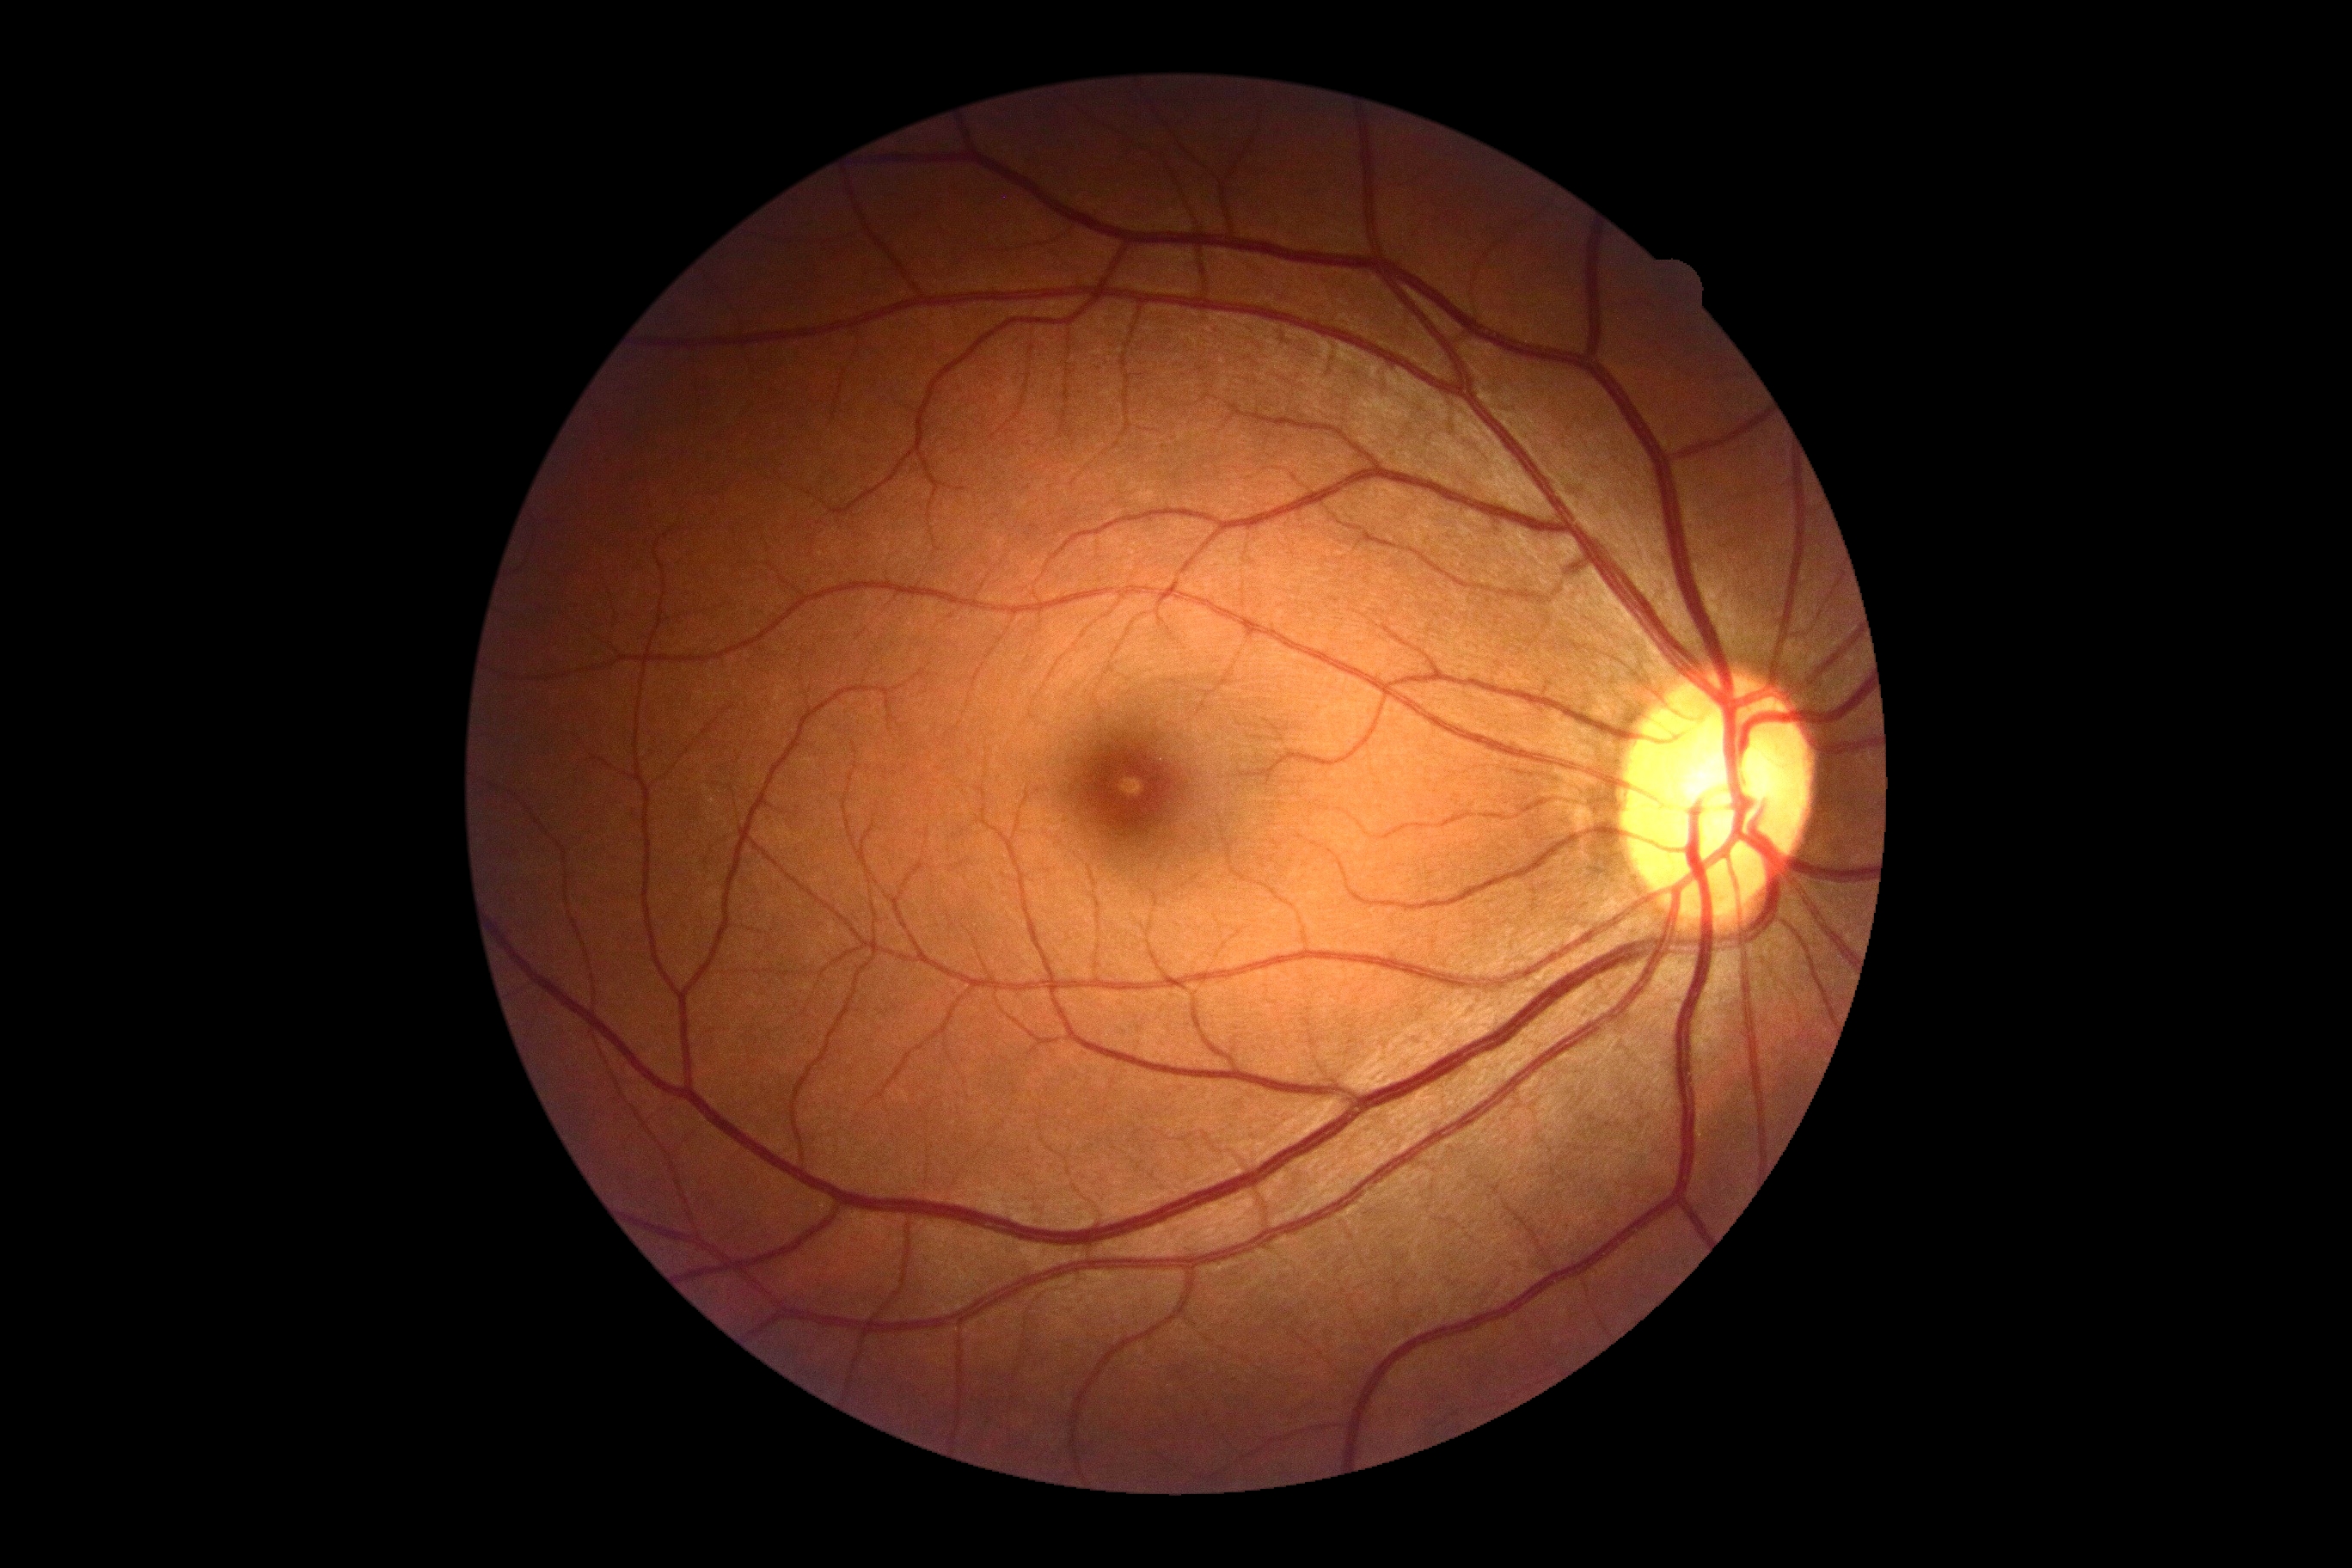
No apparent diabetic retinopathy.
DR grade: 0/4.